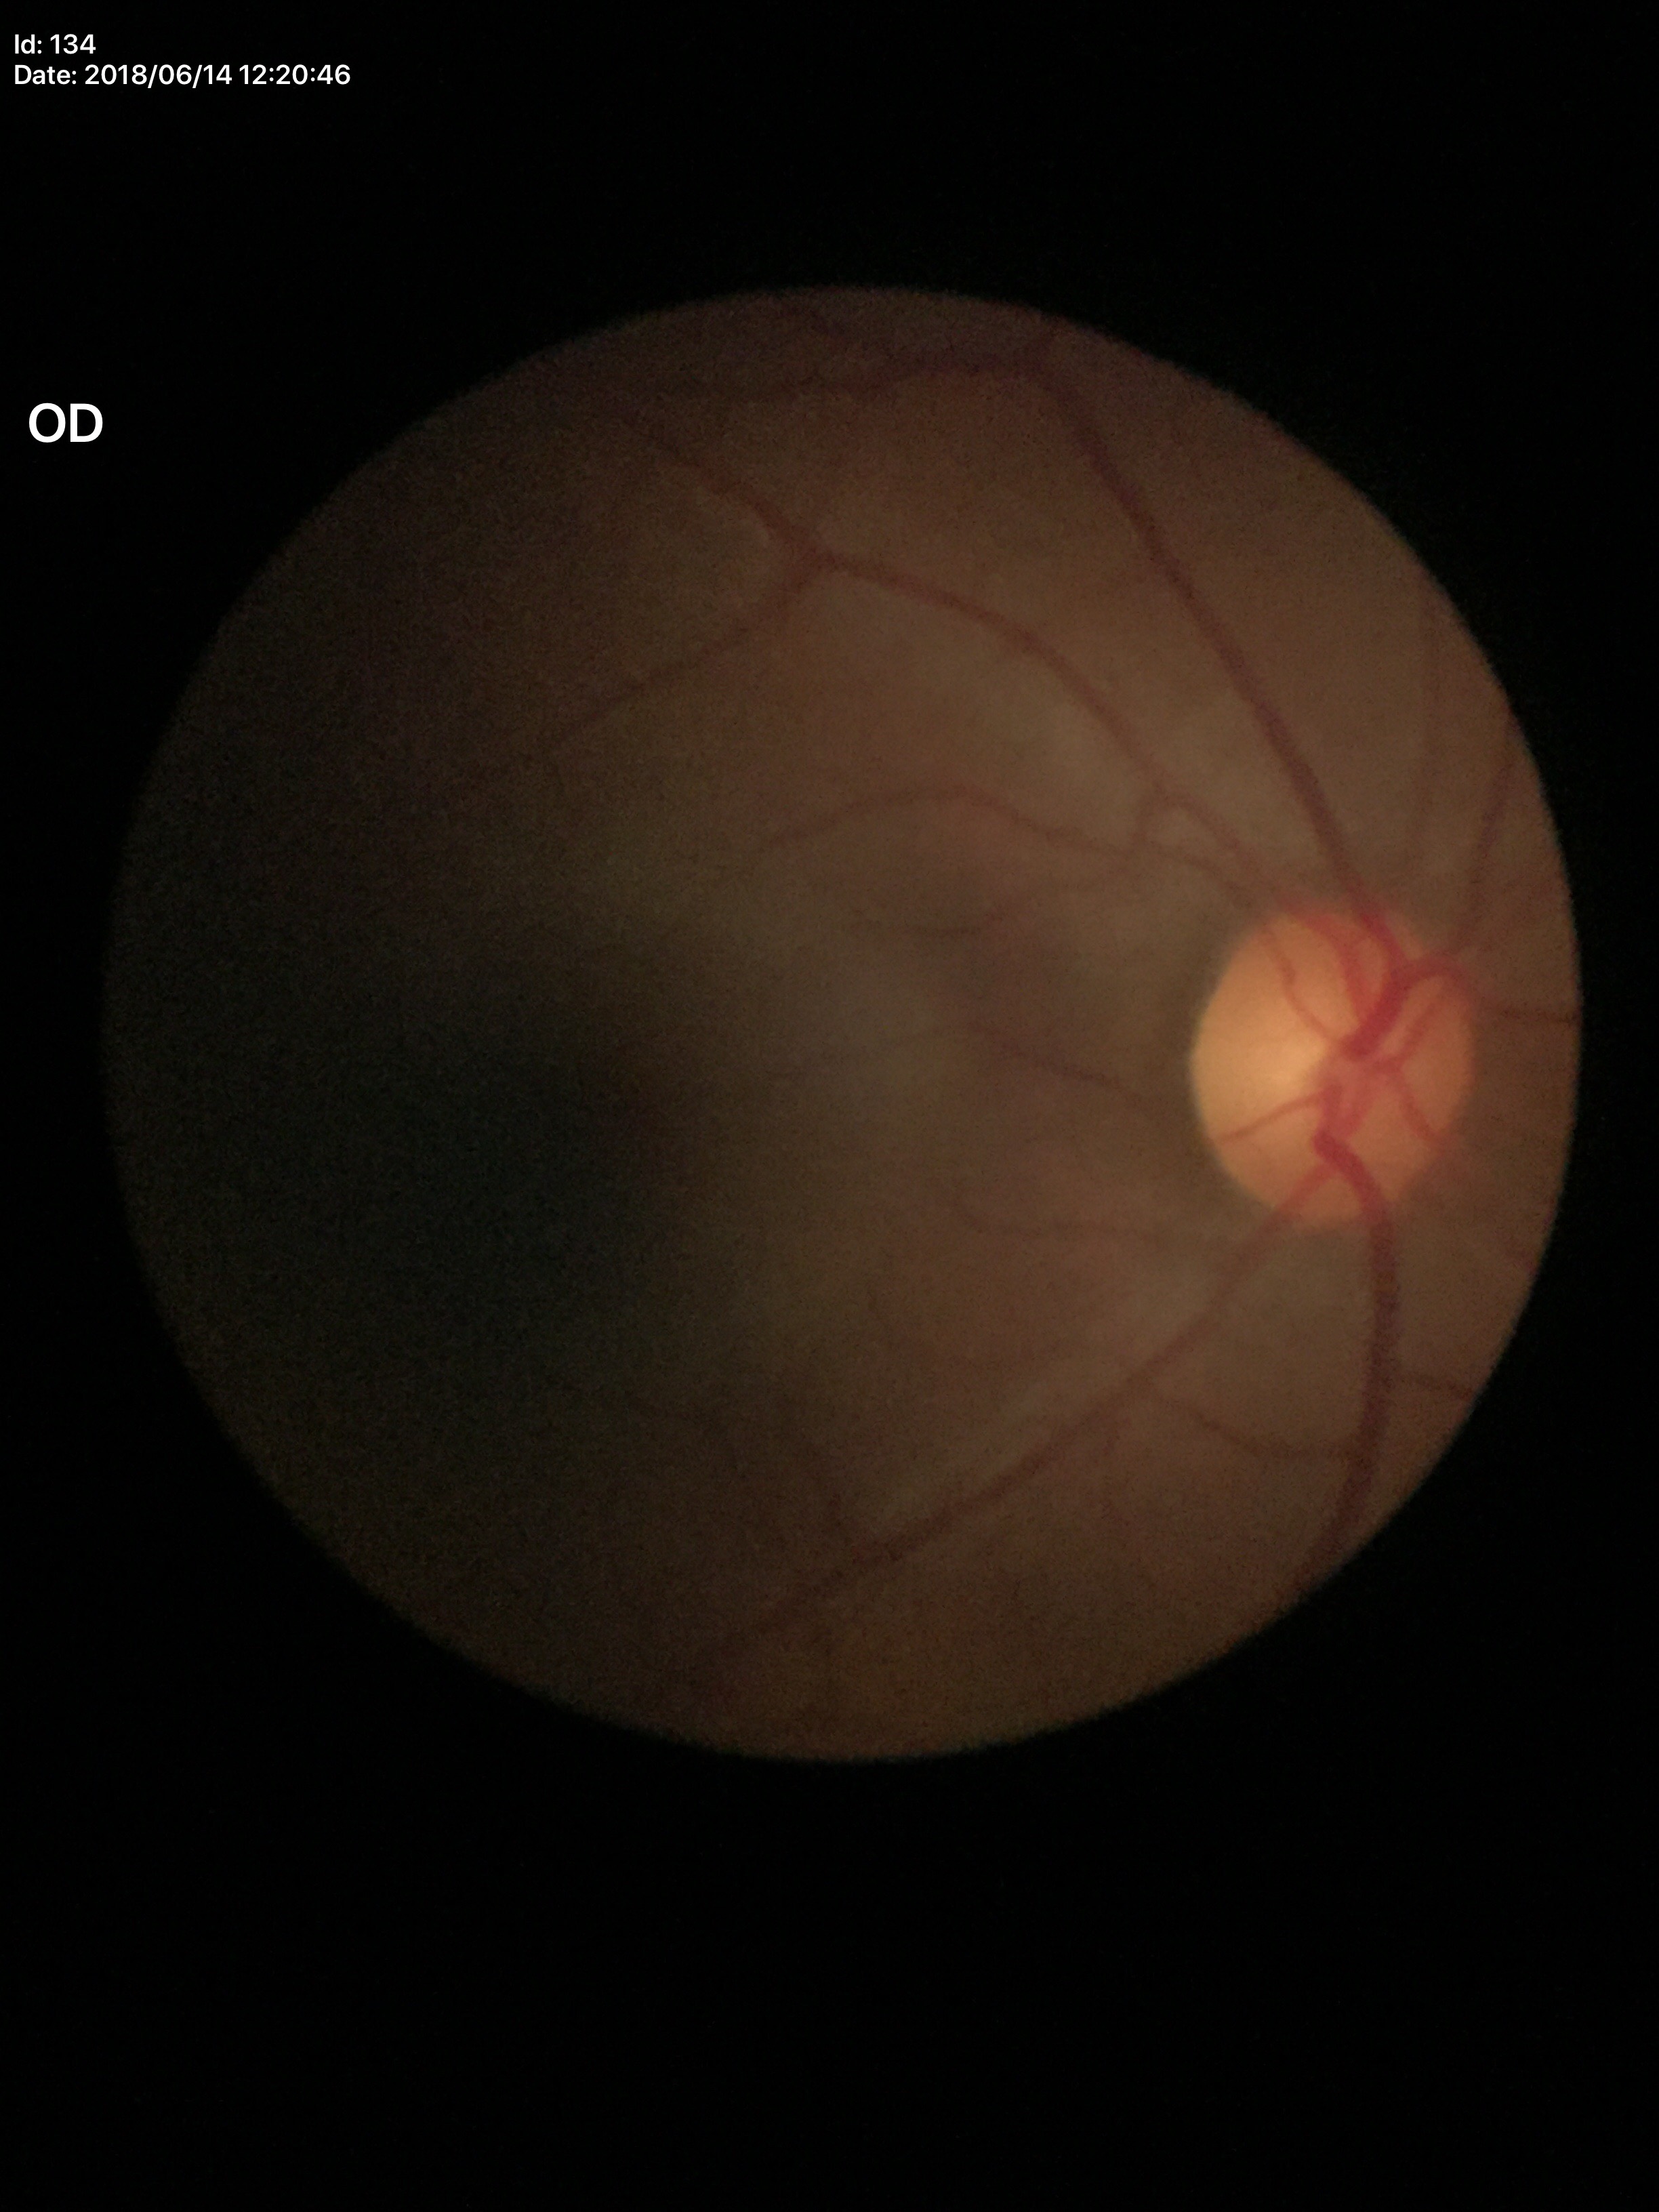 No evidence of glaucoma. HCDR of 0.51. VCDR: 0.49.